848 x 848 pixels.
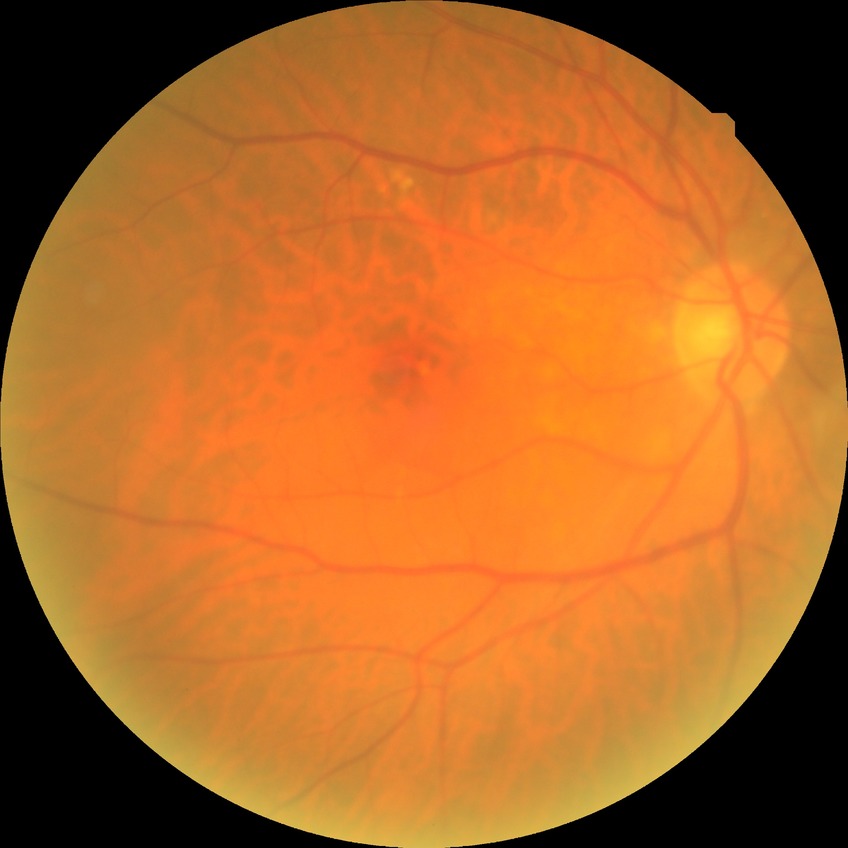 Retinopathy stage is no diabetic retinopathy.